FOV: 45 degrees: 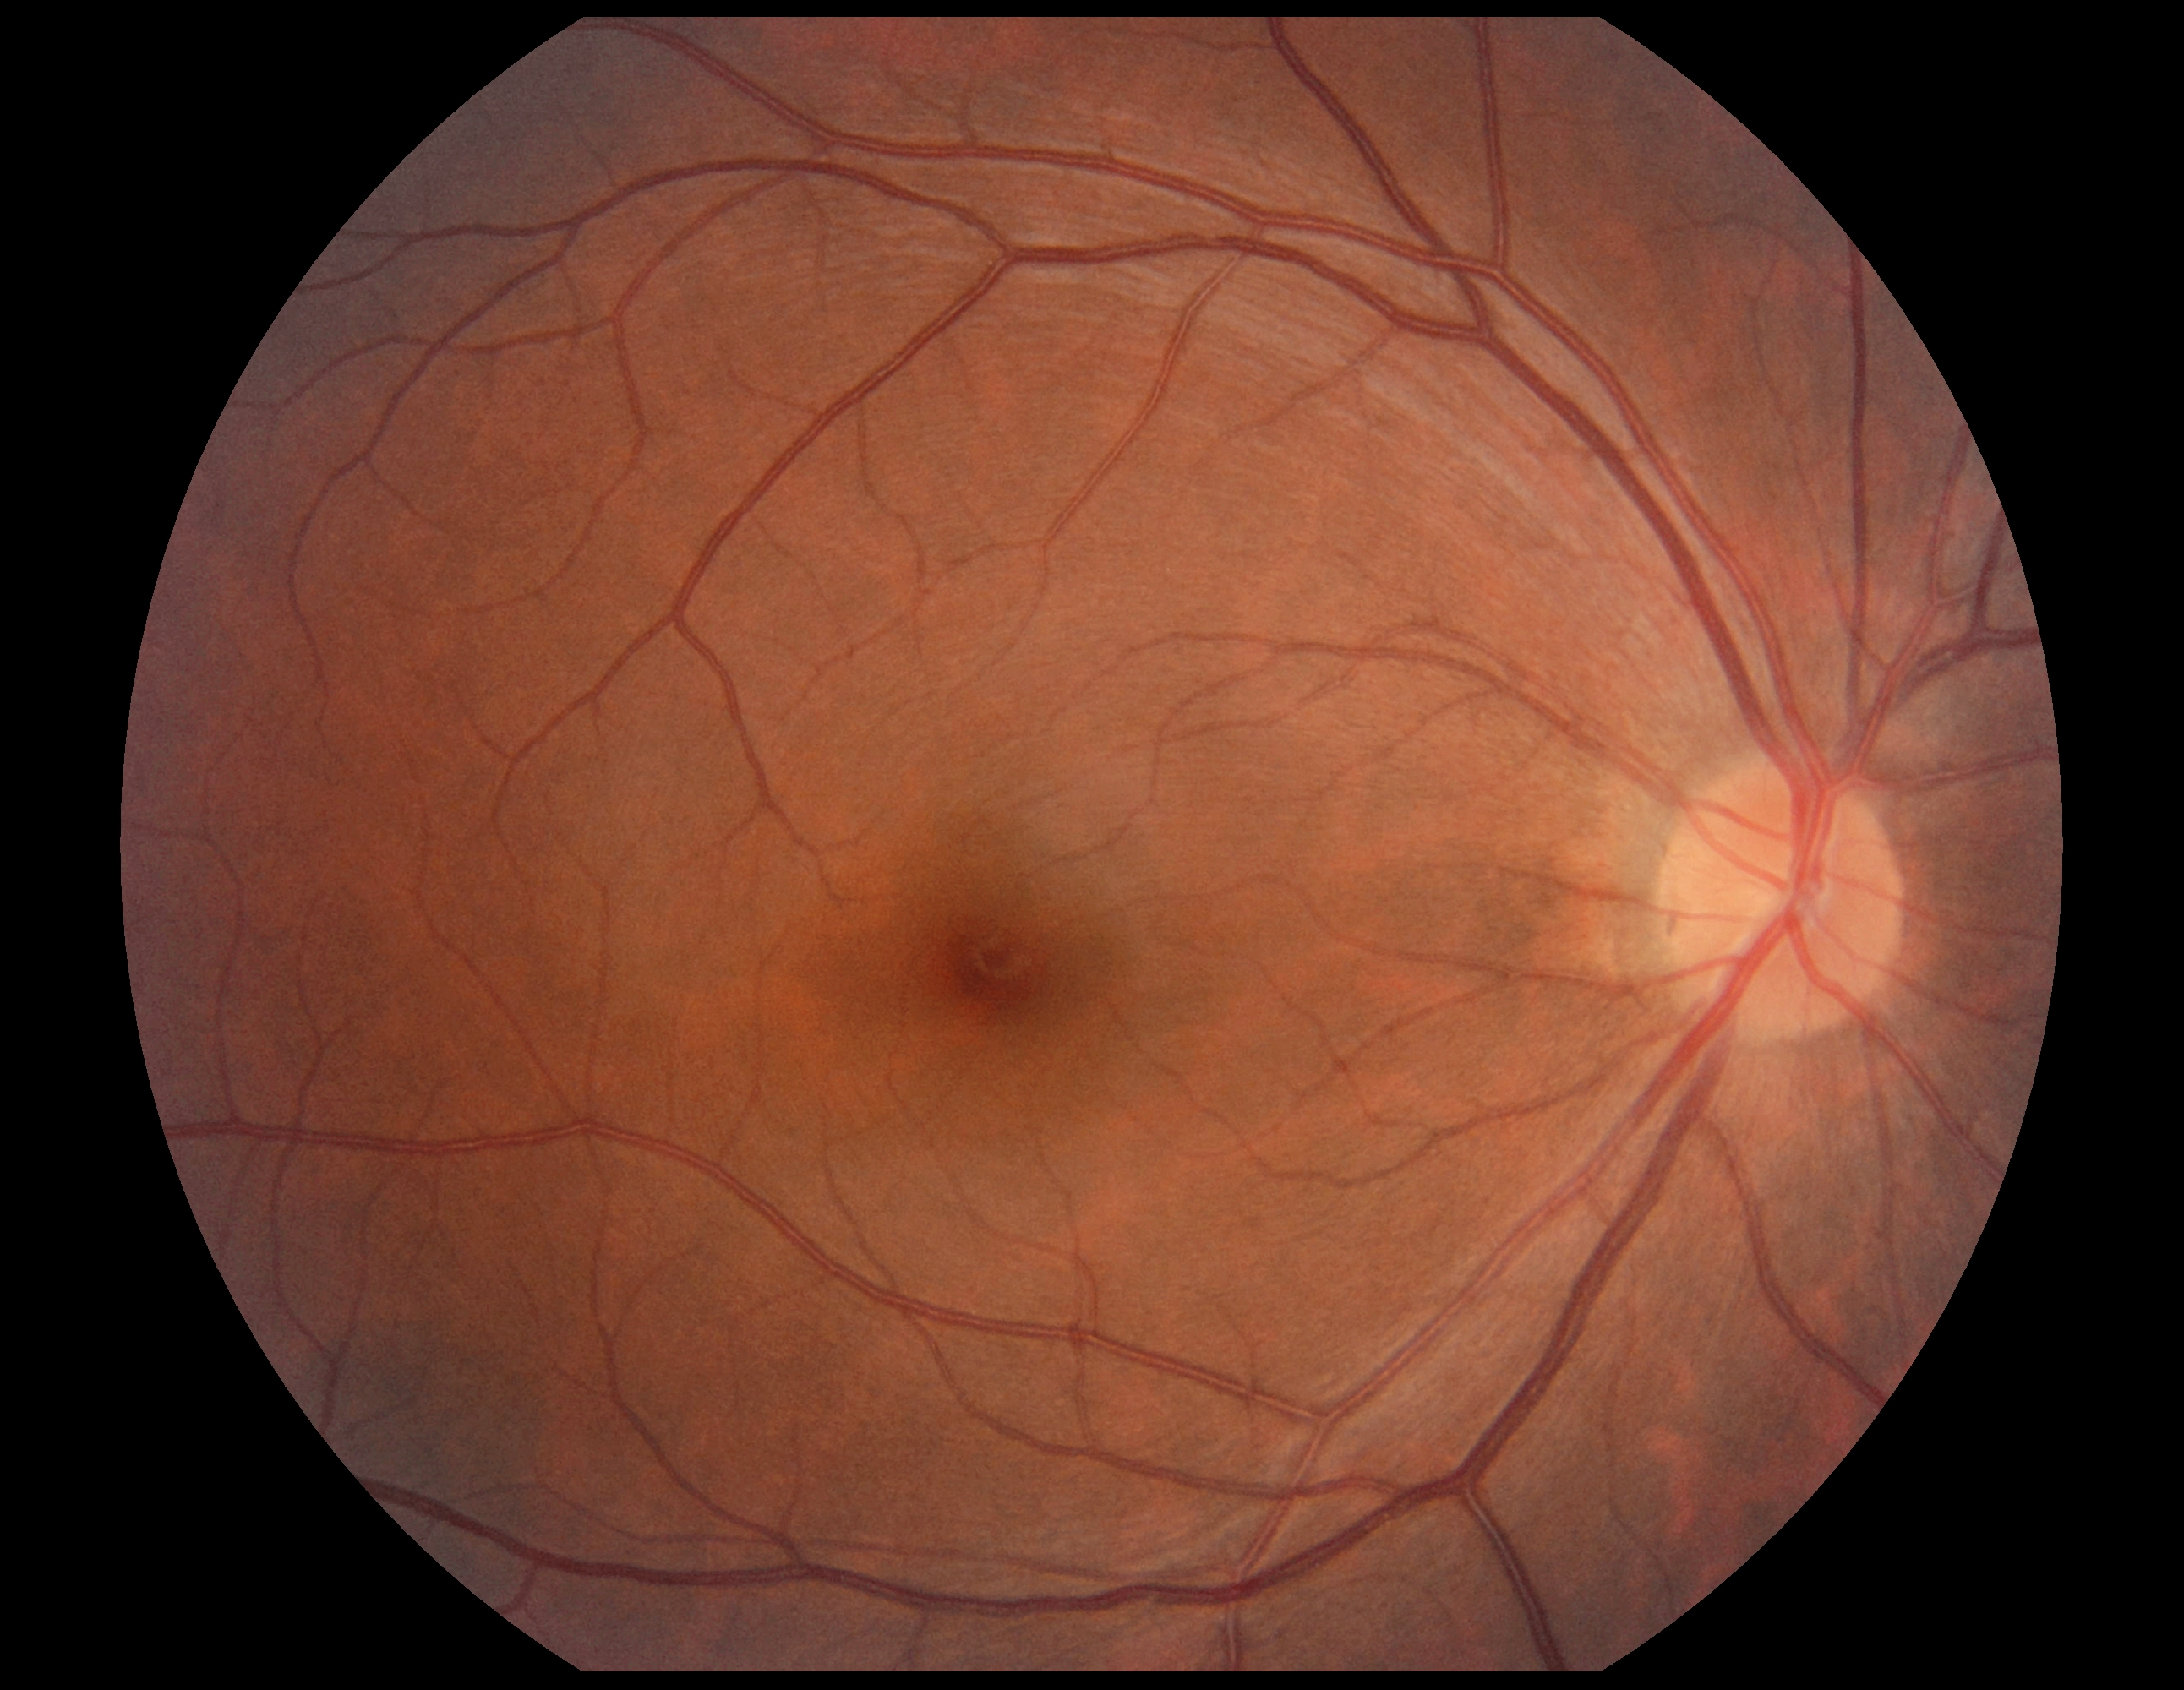 No signs of diabetic retinopathy. DR grade: 0 — no visible signs of diabetic retinopathy.